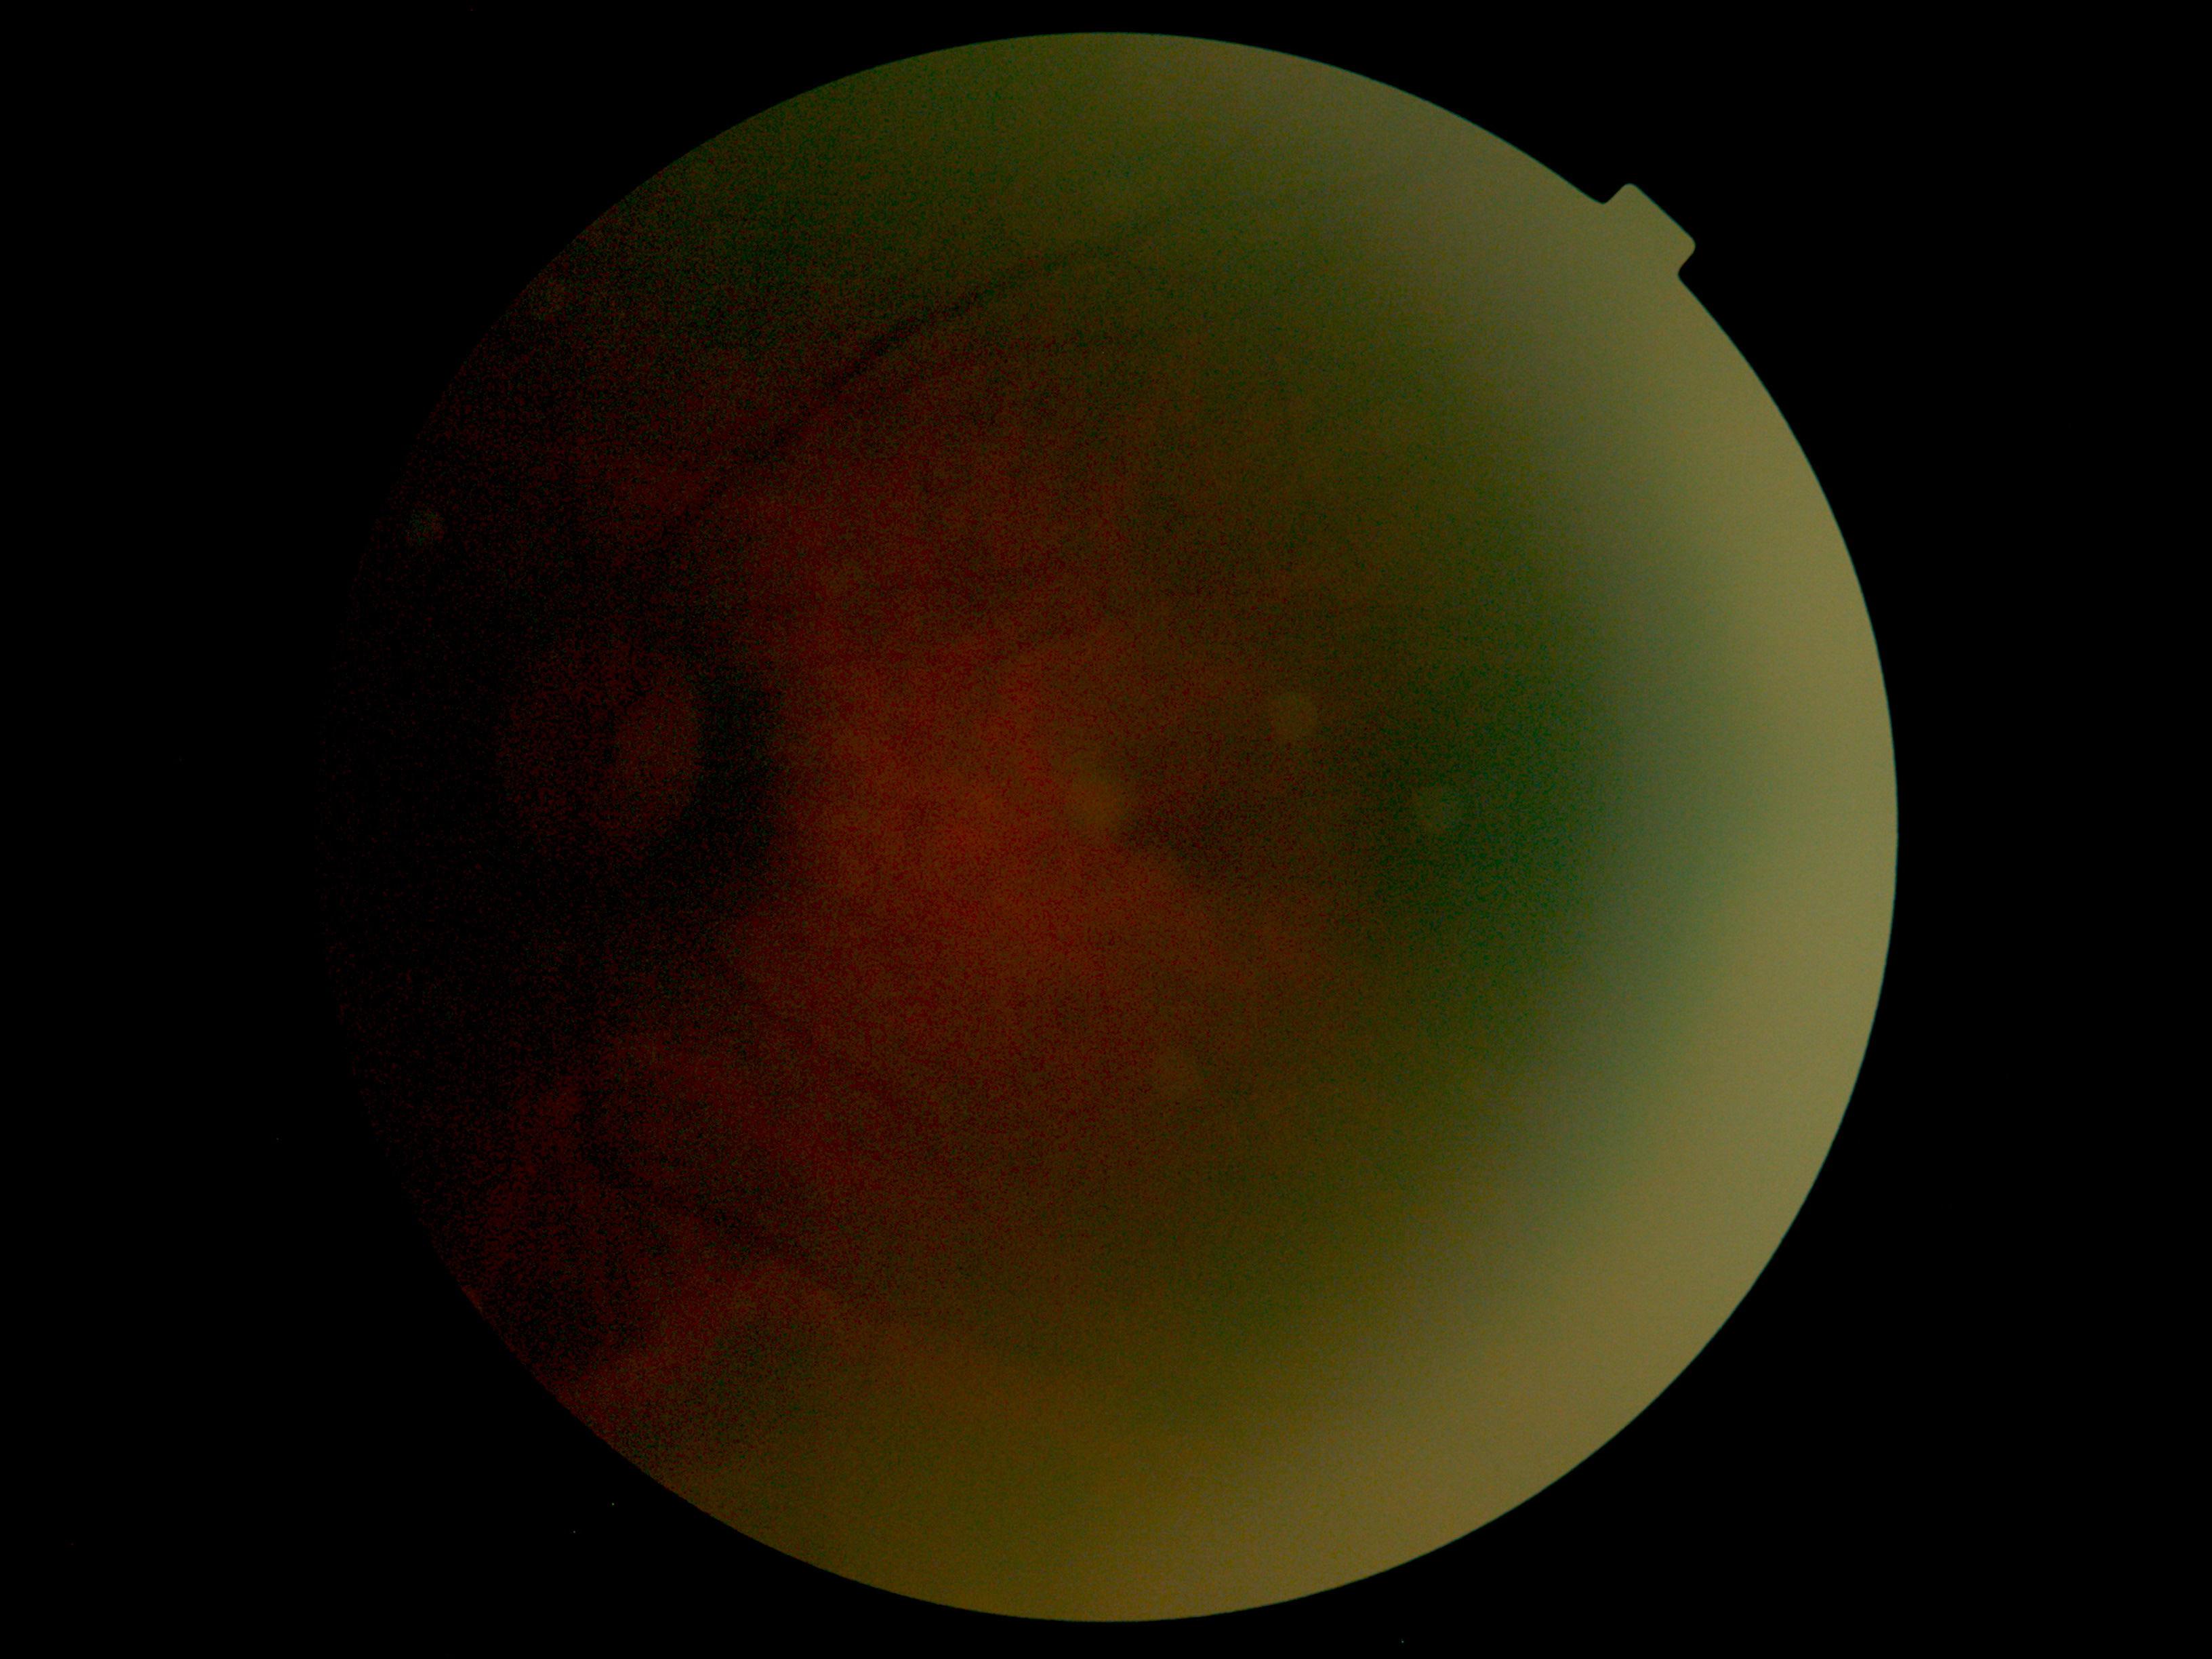
dr_grade: ungradable
quality: below grading threshold